DR severity per modified Davis staging.
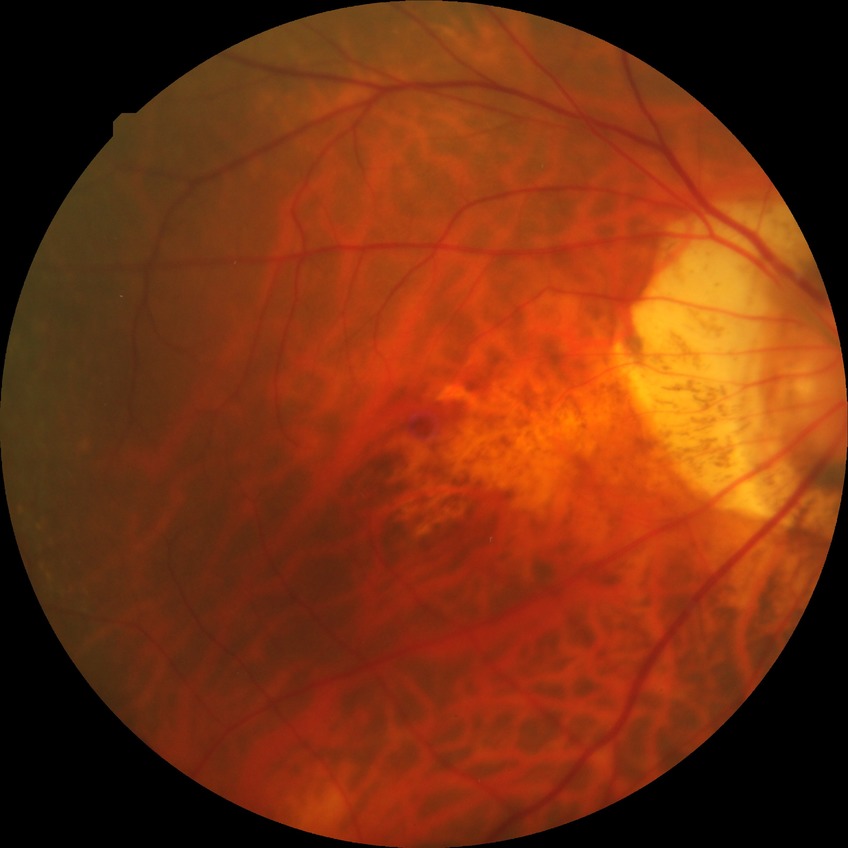
modified Davis classification: no diabetic retinopathy